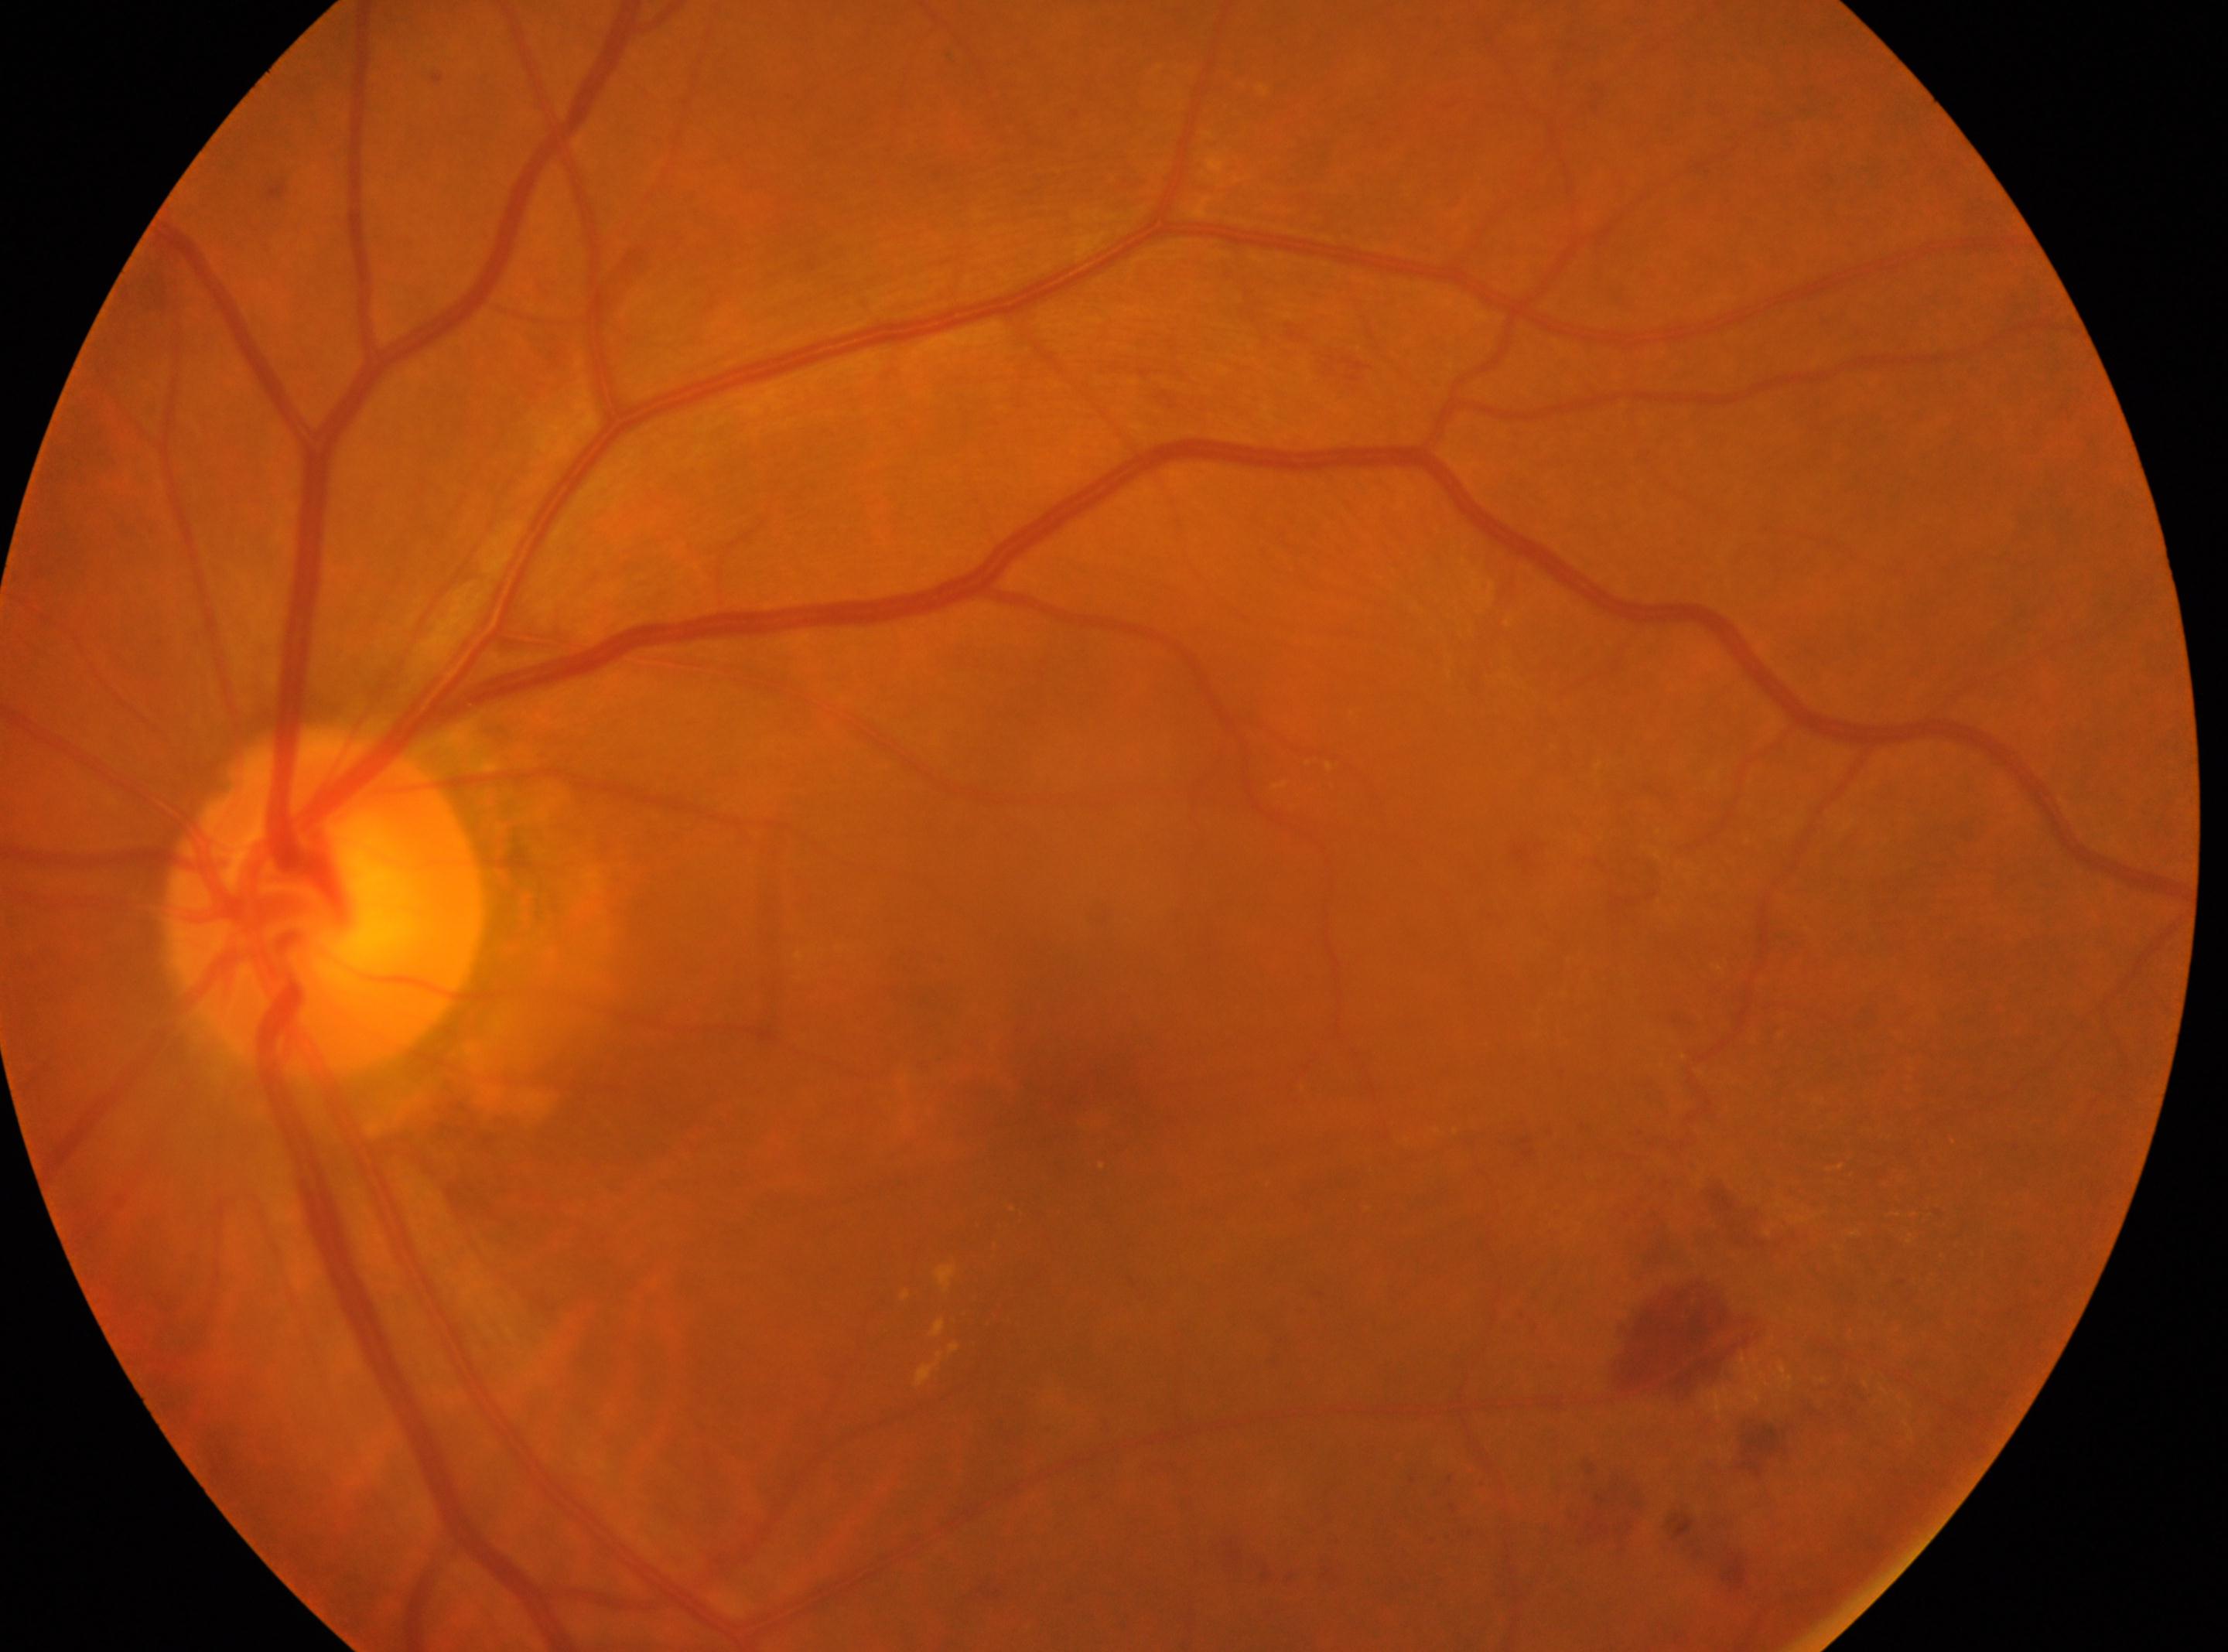

• laterality: left eye
• ONH: 326, 900
• DR severity: grade 2 (moderate NPDR)
• fovea center: 1094, 1109